FOV: 50 degrees. Camera: Topcon TRC-50DX. 2228x1652. Posterior pole field covering the optic disc and macula: 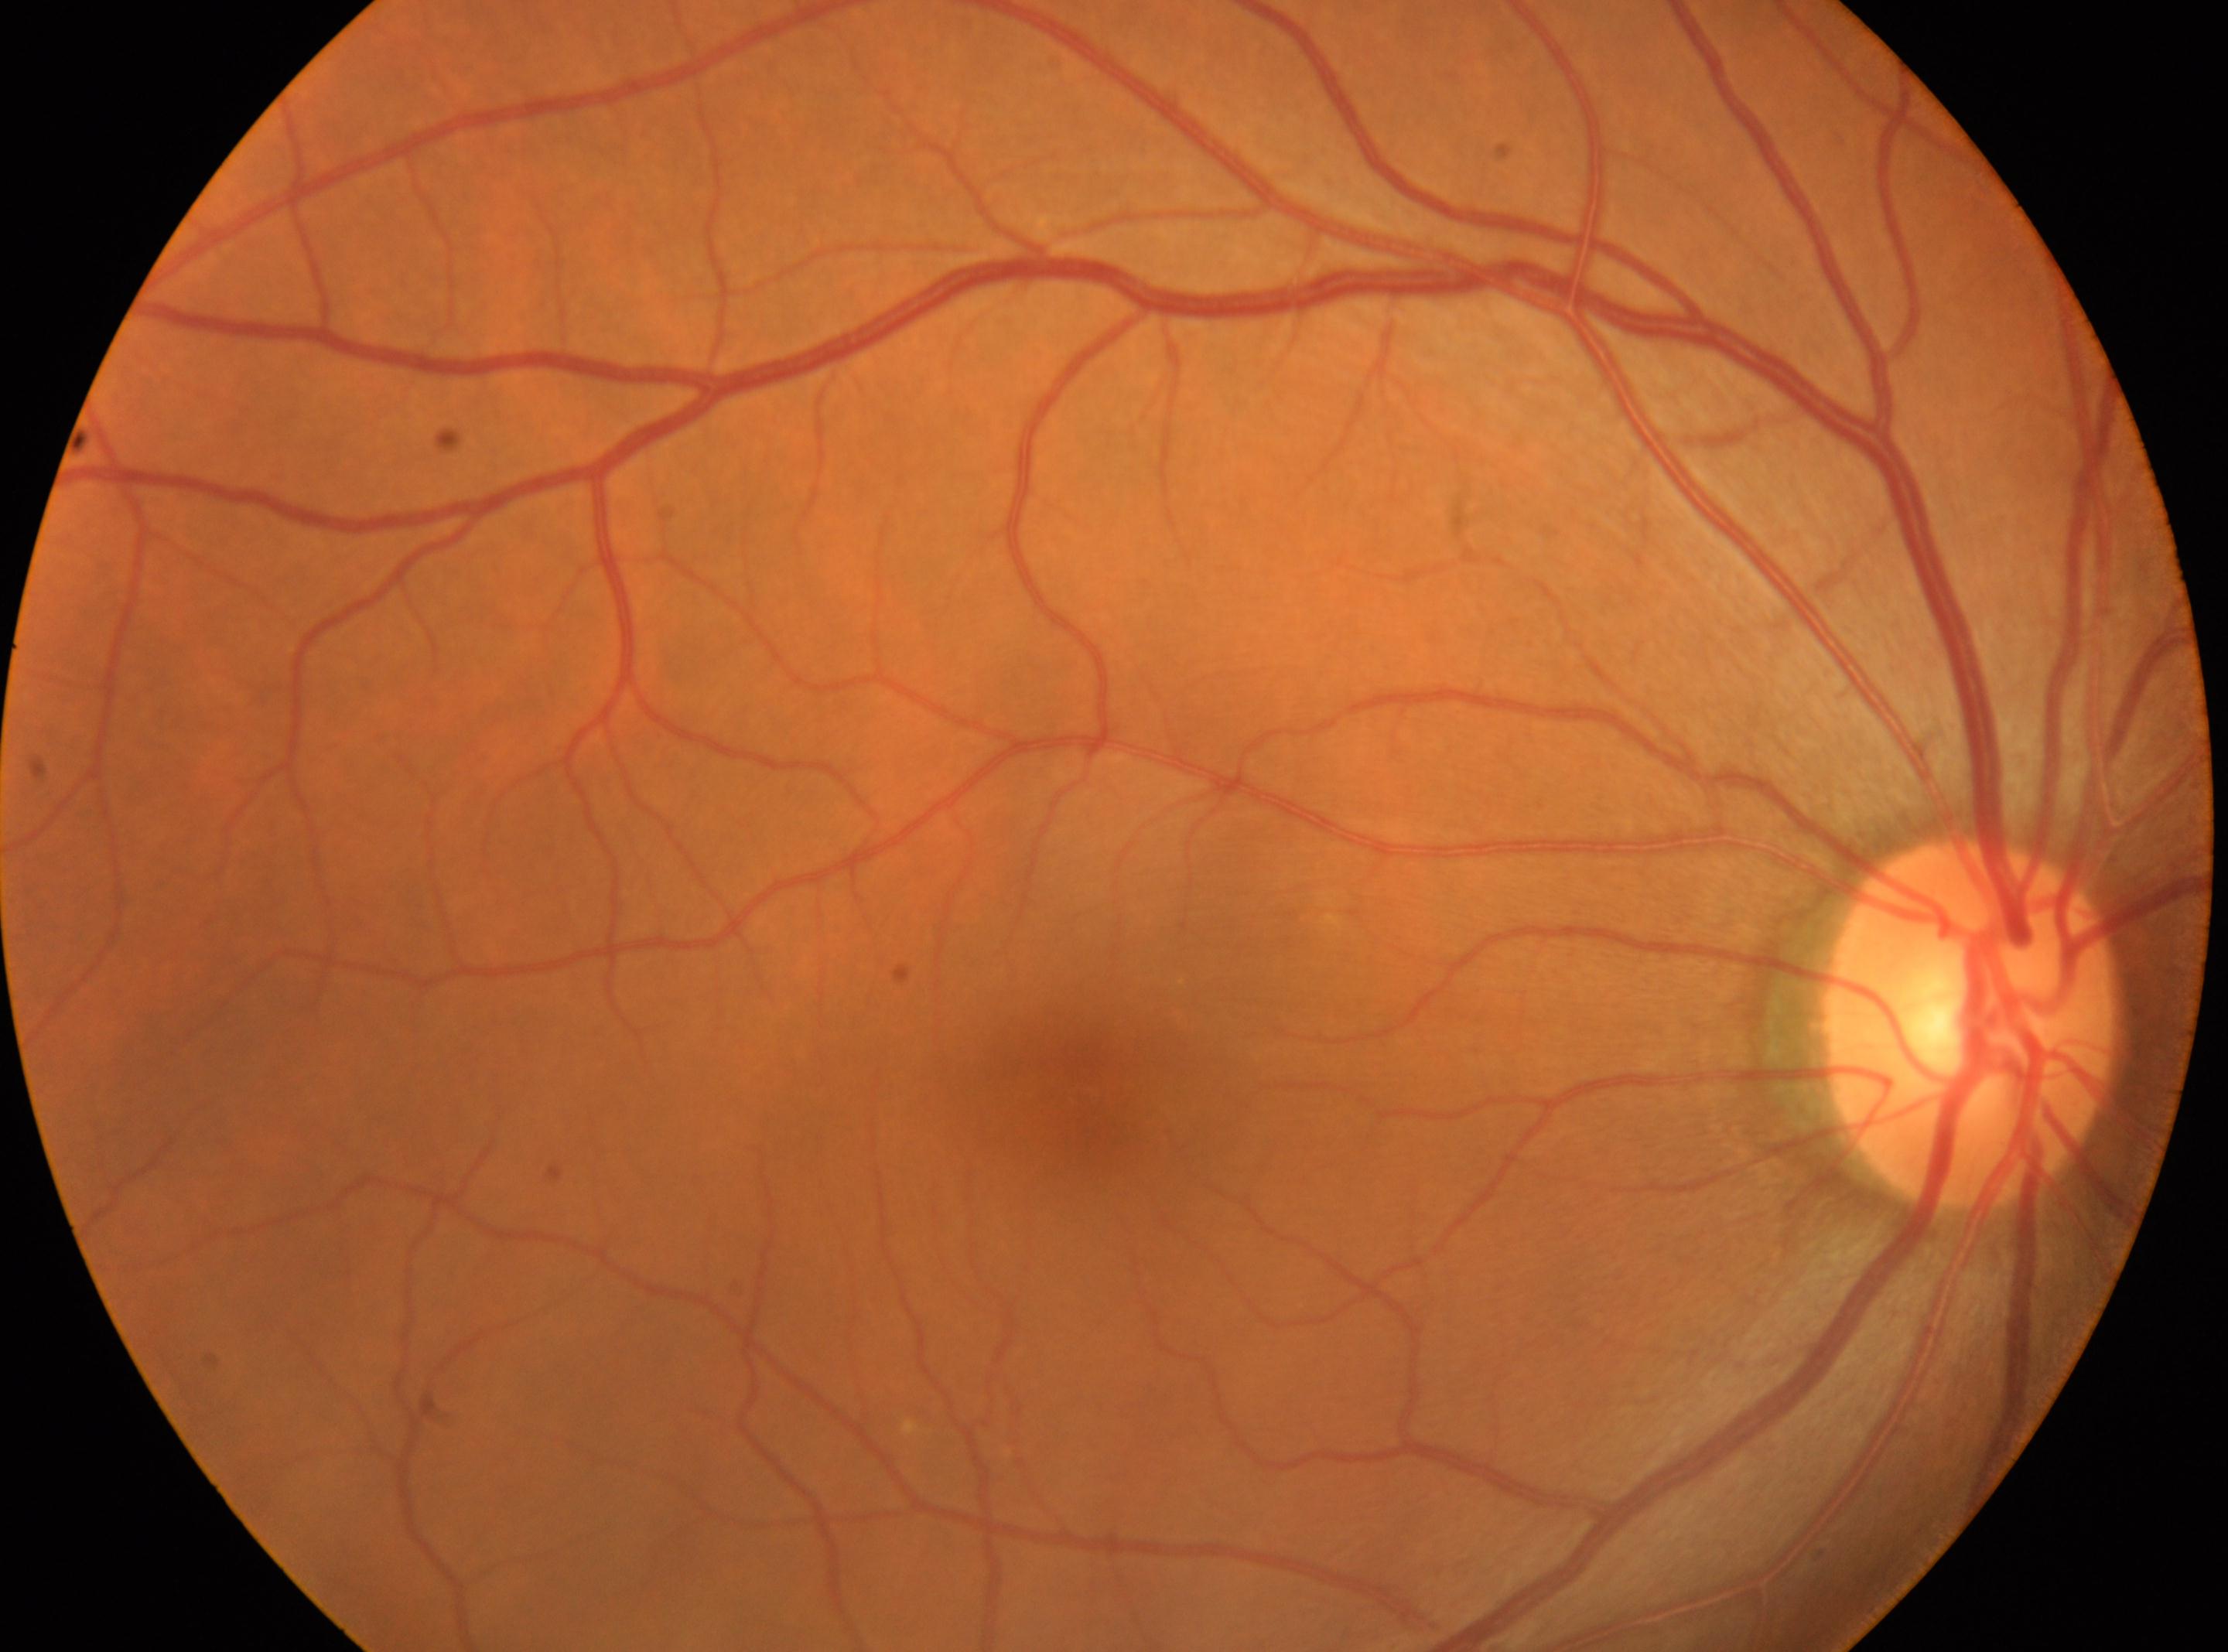 Findings:
- fovea center: (1080,1106)
- ONH: (1973,1024)
- DR stage: 0/4
- laterality: right